Color fundus photograph; 45° FOV
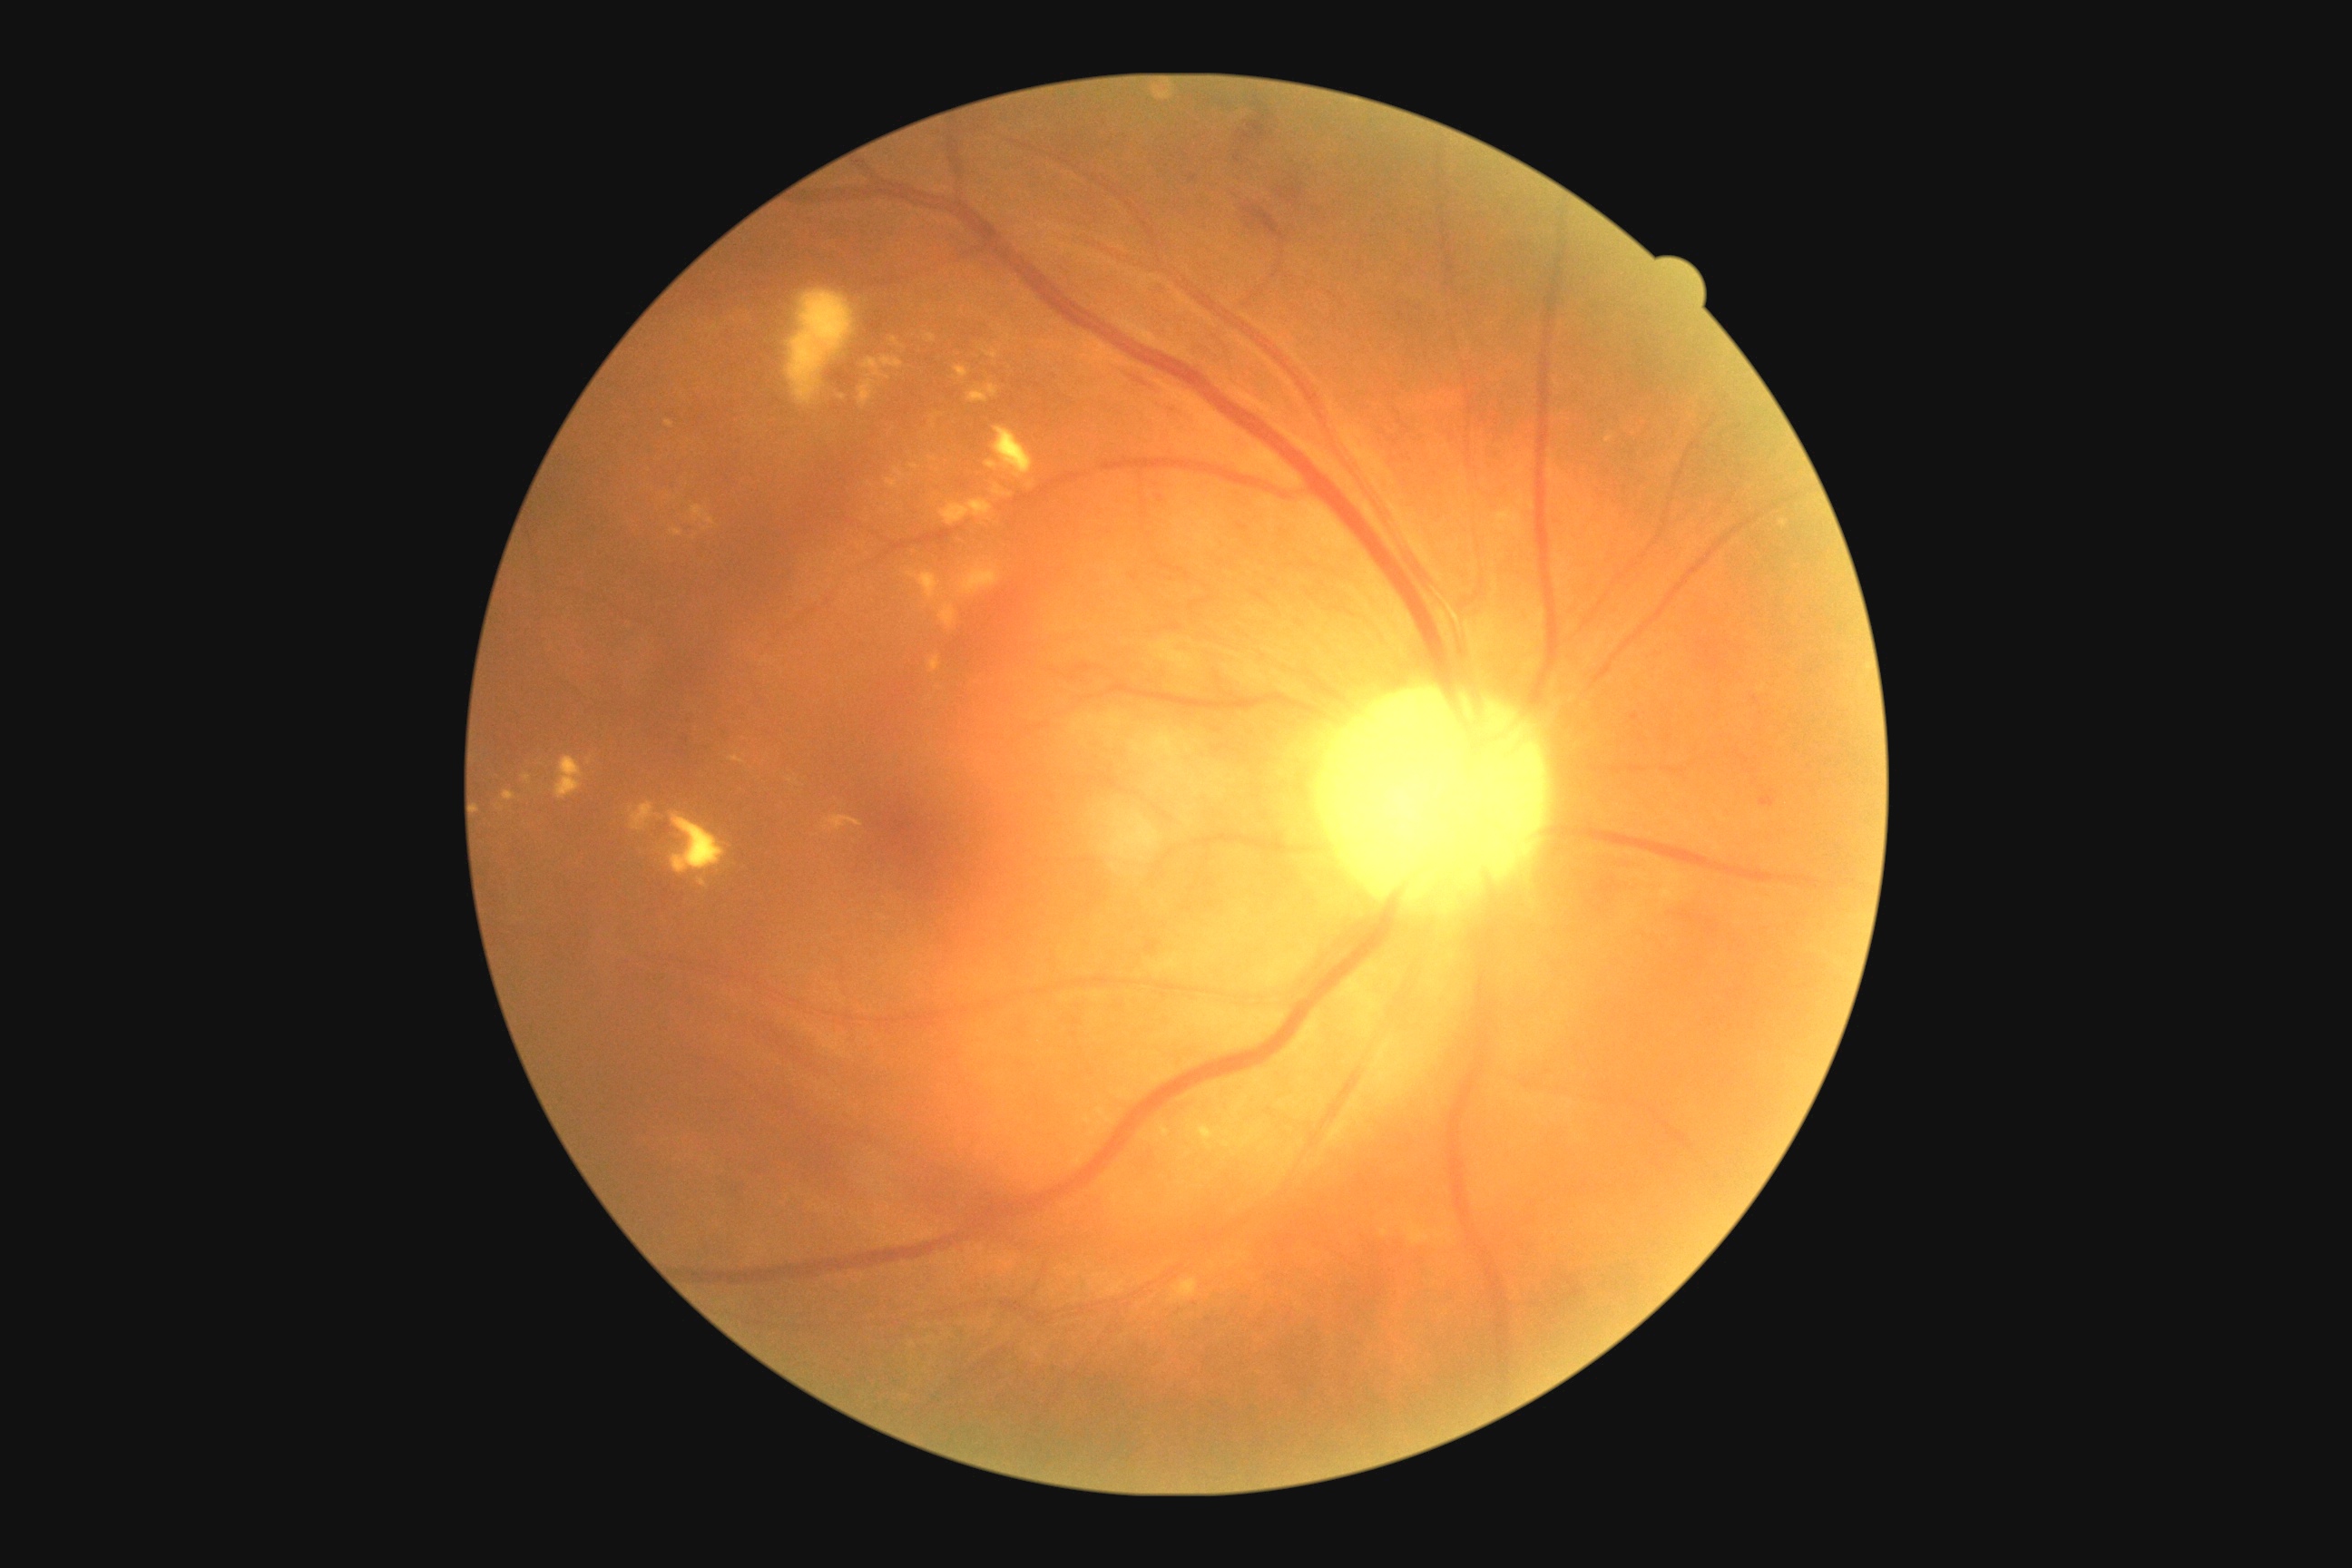

DR grade is moderate non-proliferative diabetic retinopathy (2).